Acquired on the Phoenix ICON; wide-field fundus image from infant ROP screening:
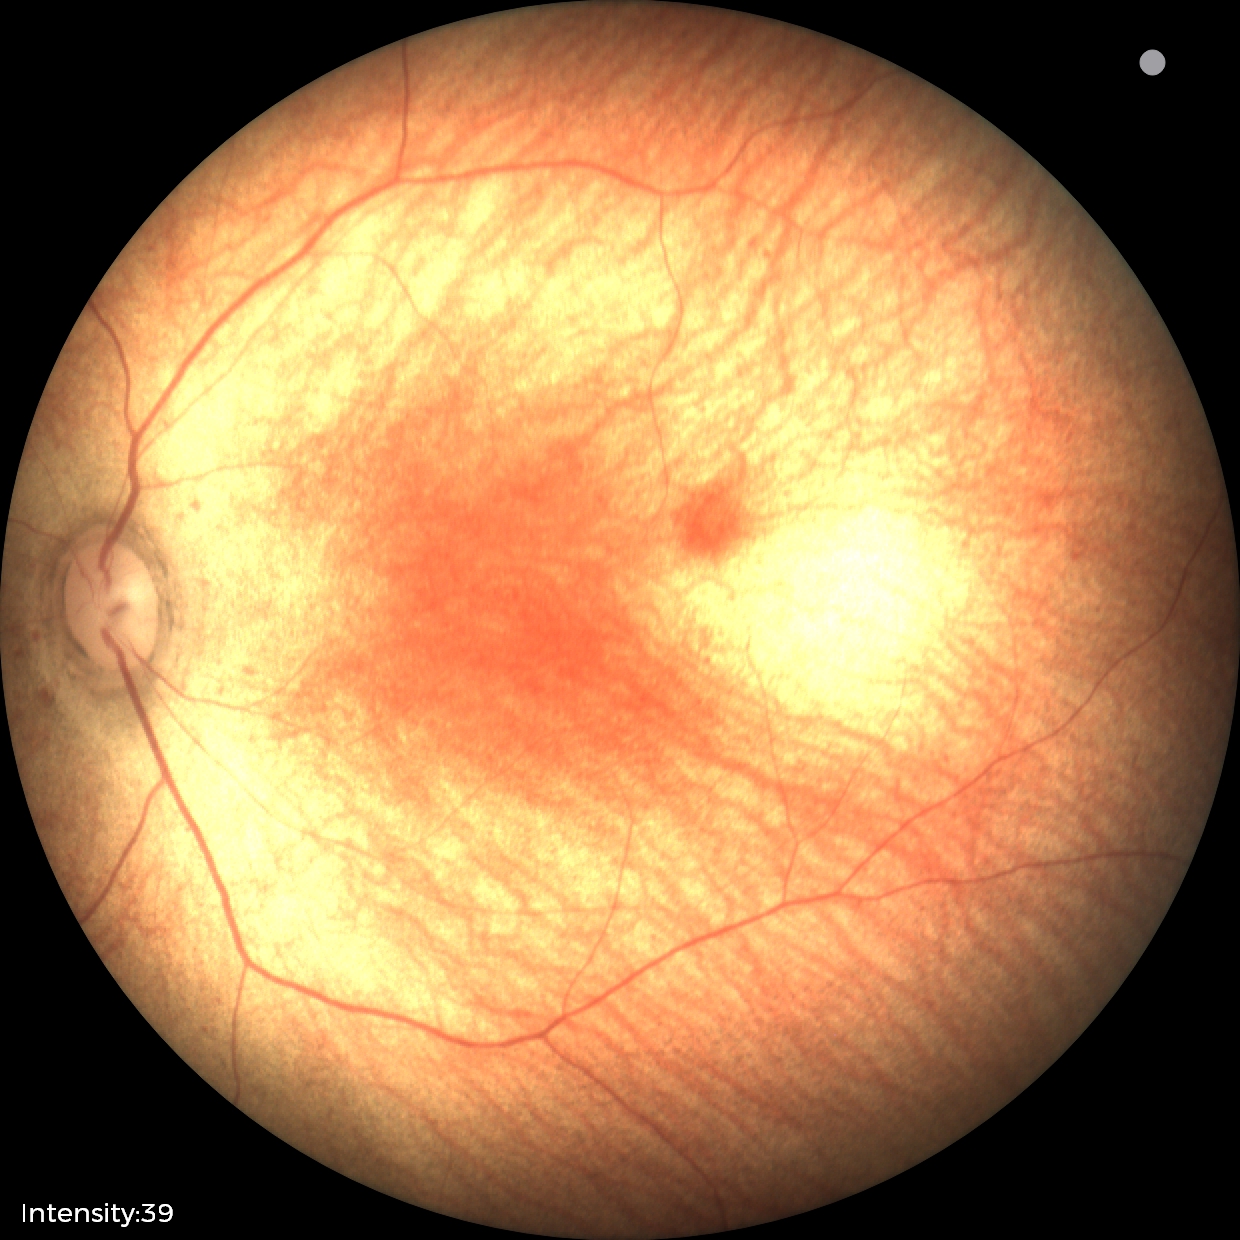

No retinal pathology identified on screening.